45° FOV — 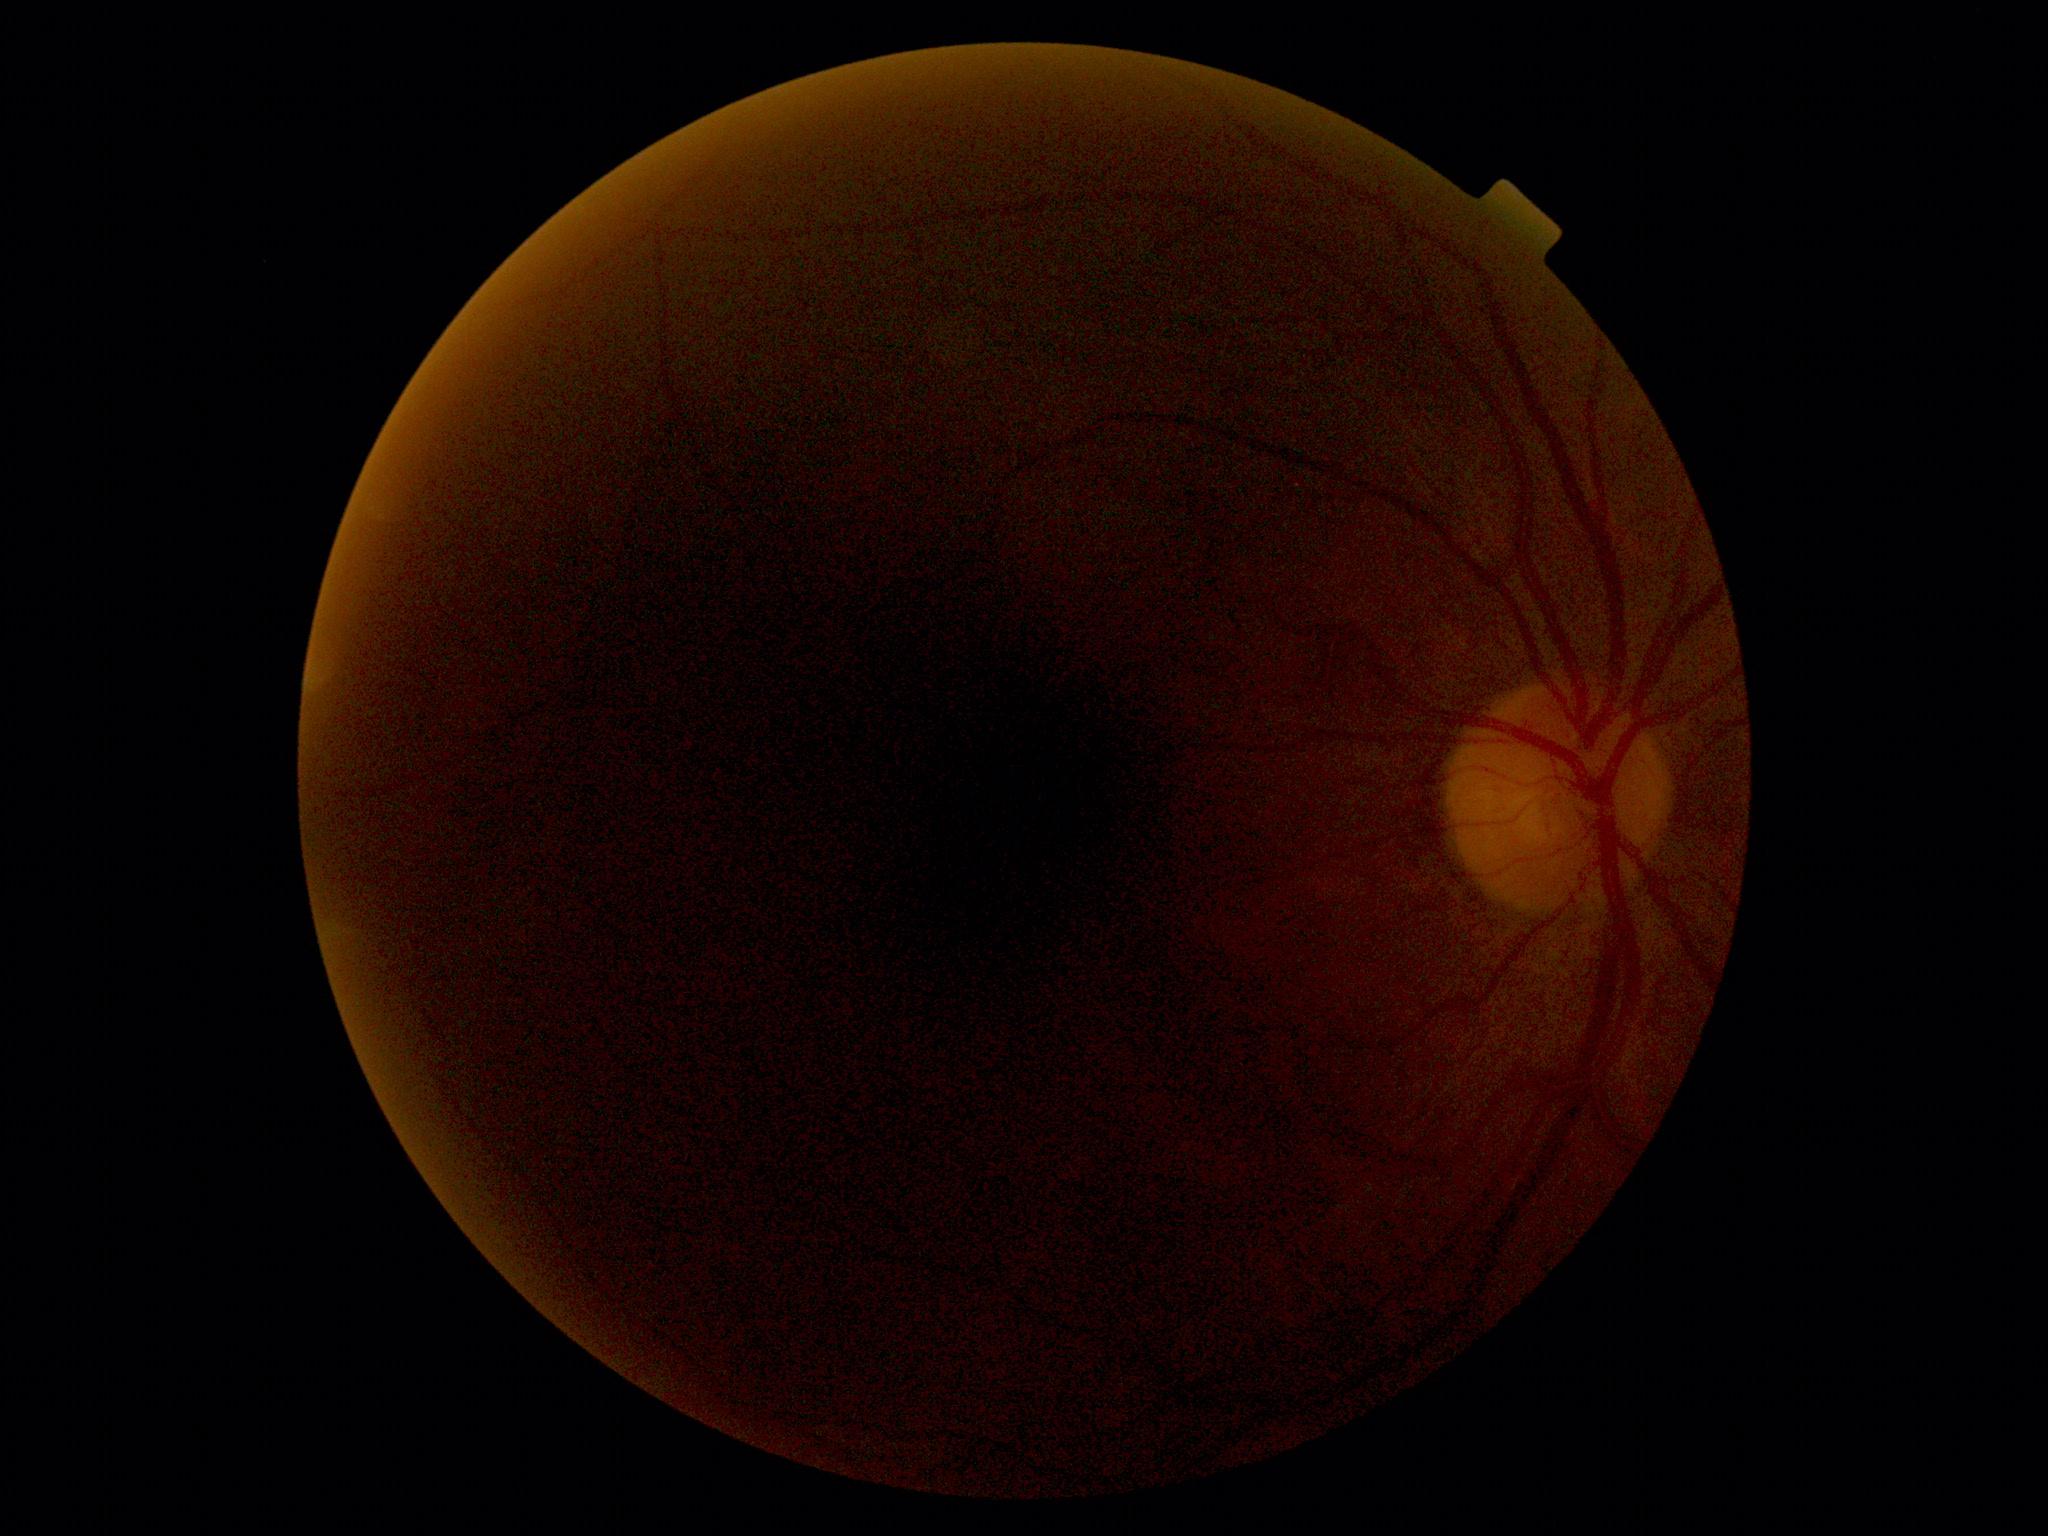

image quality: below grading threshold; diabetic retinopathy (DR): ungradable.